2352 by 1568 pixels. Fundus photo. 45-degree field of view.
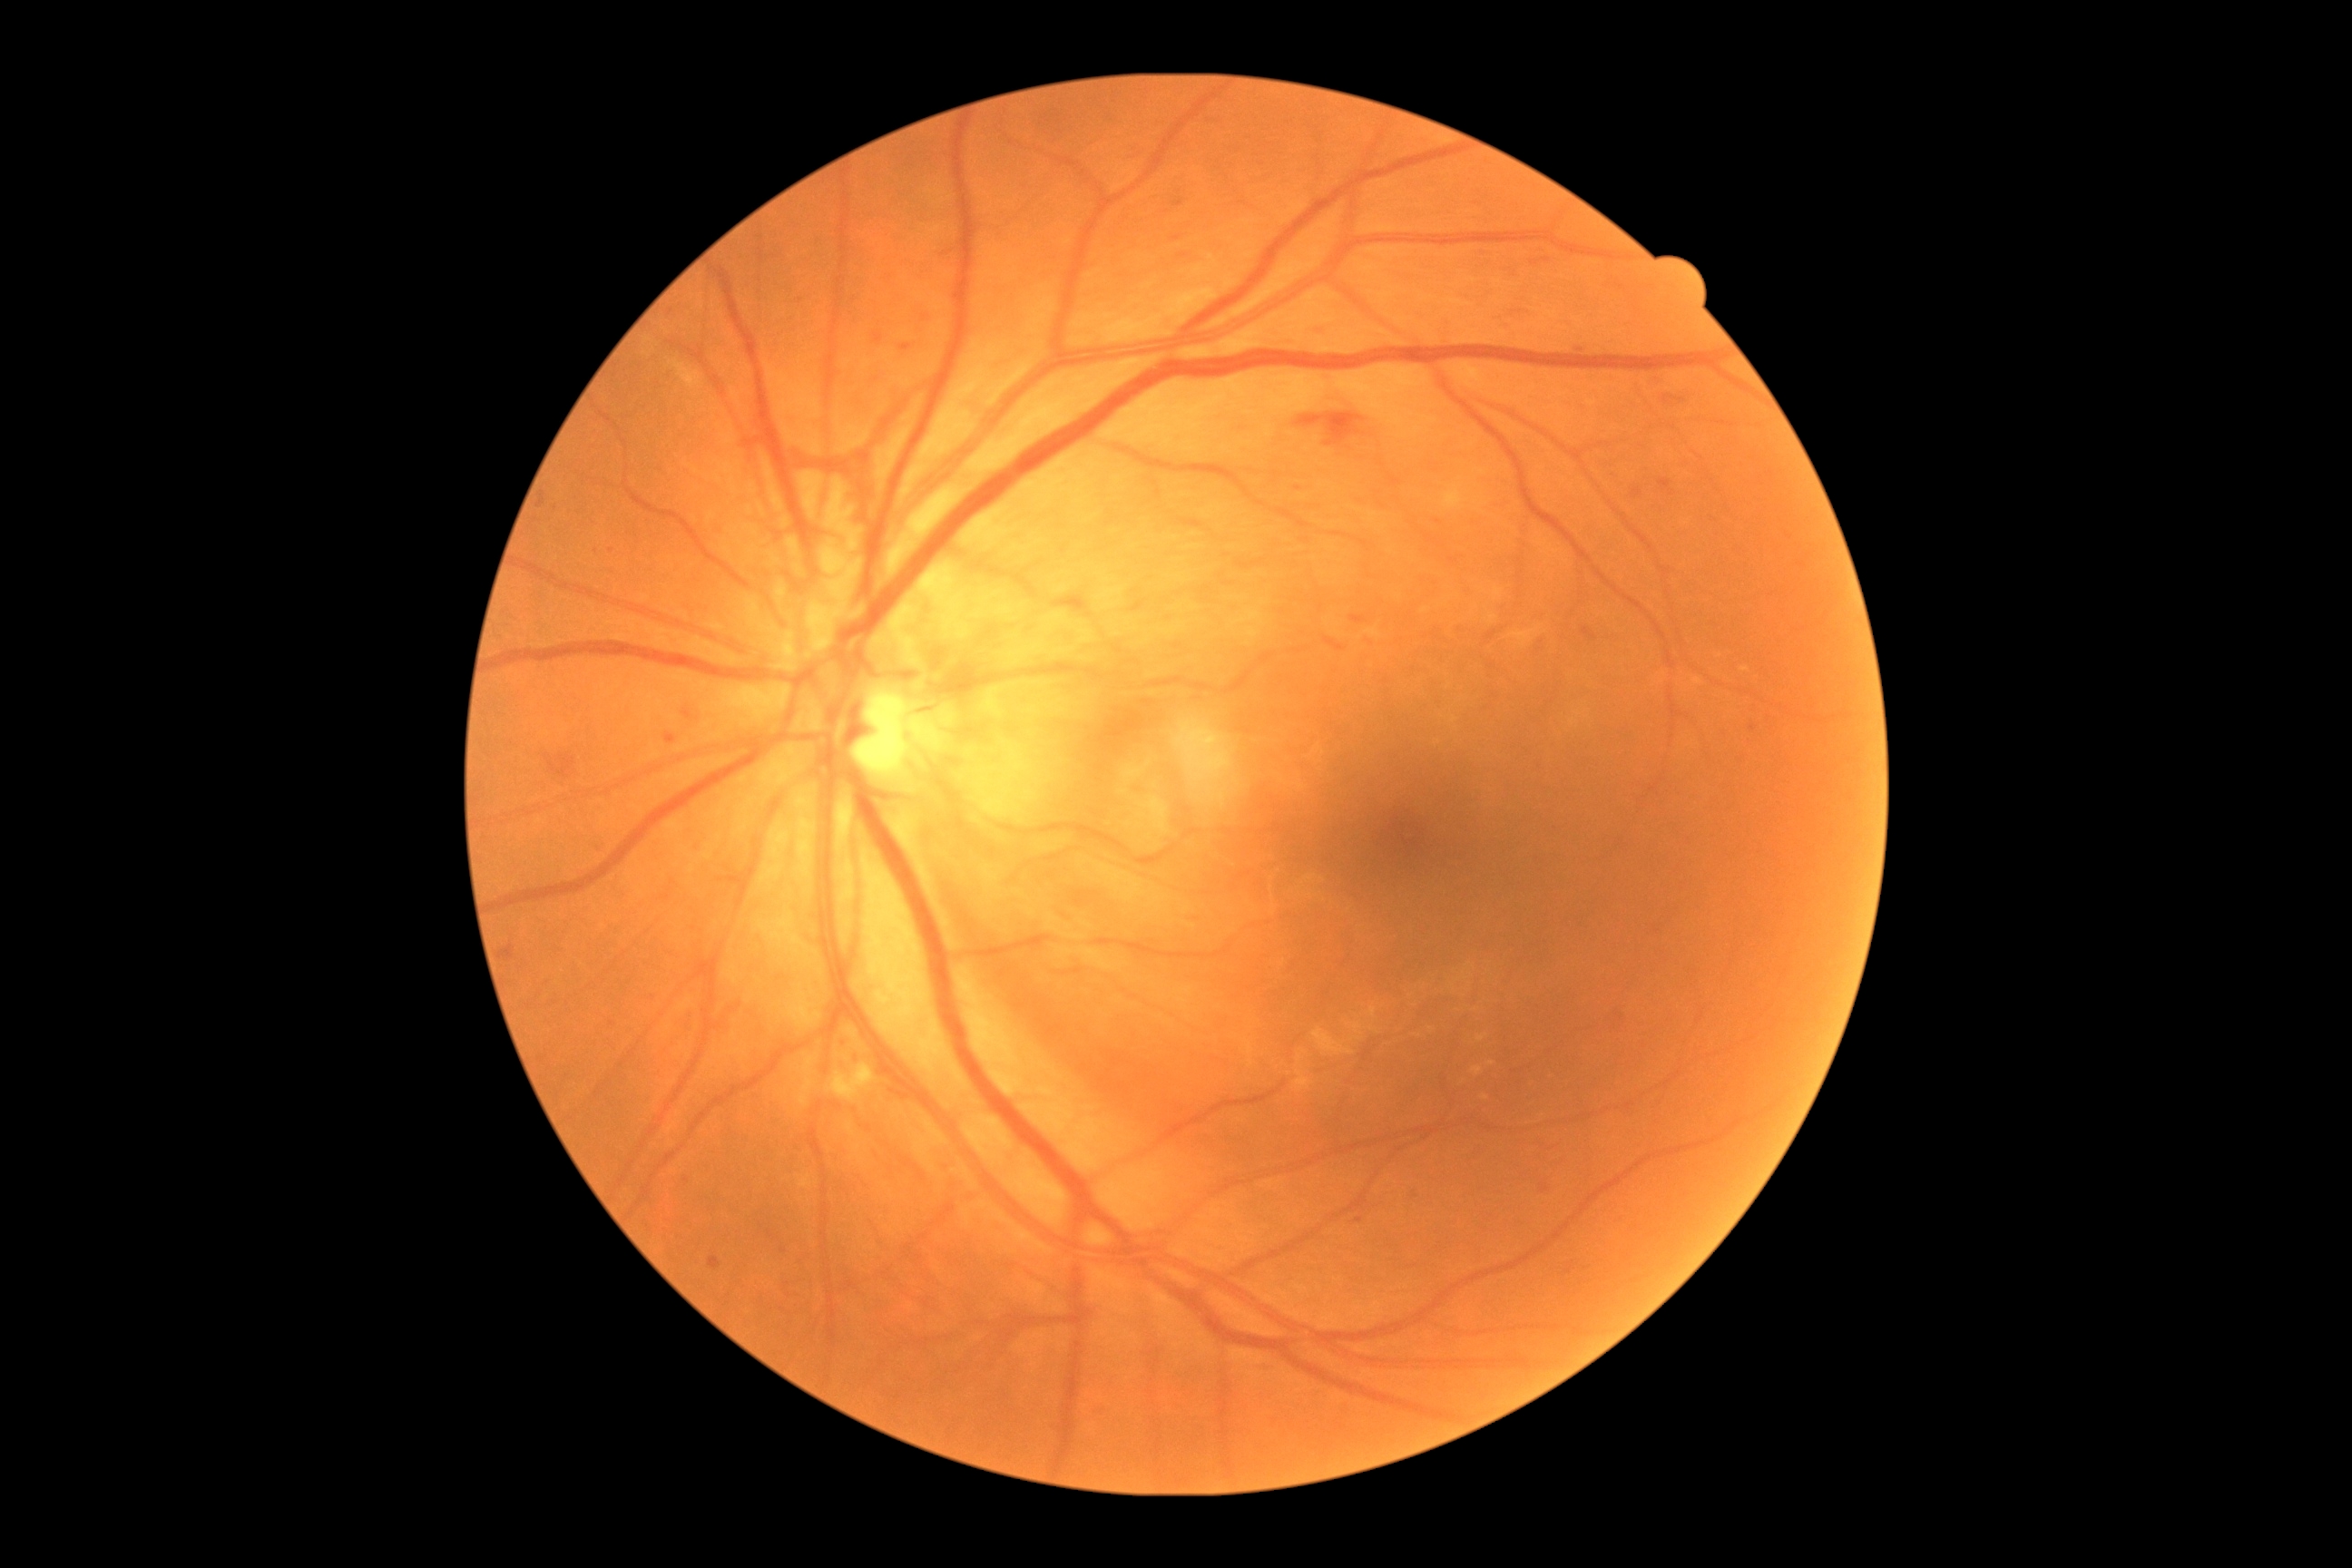

DR grade: 4/4 — neovascularization and/or vitreous/pre-retinal hemorrhage.